Natus RetCam Envision, 130° FOV; pediatric wide-field fundus photograph
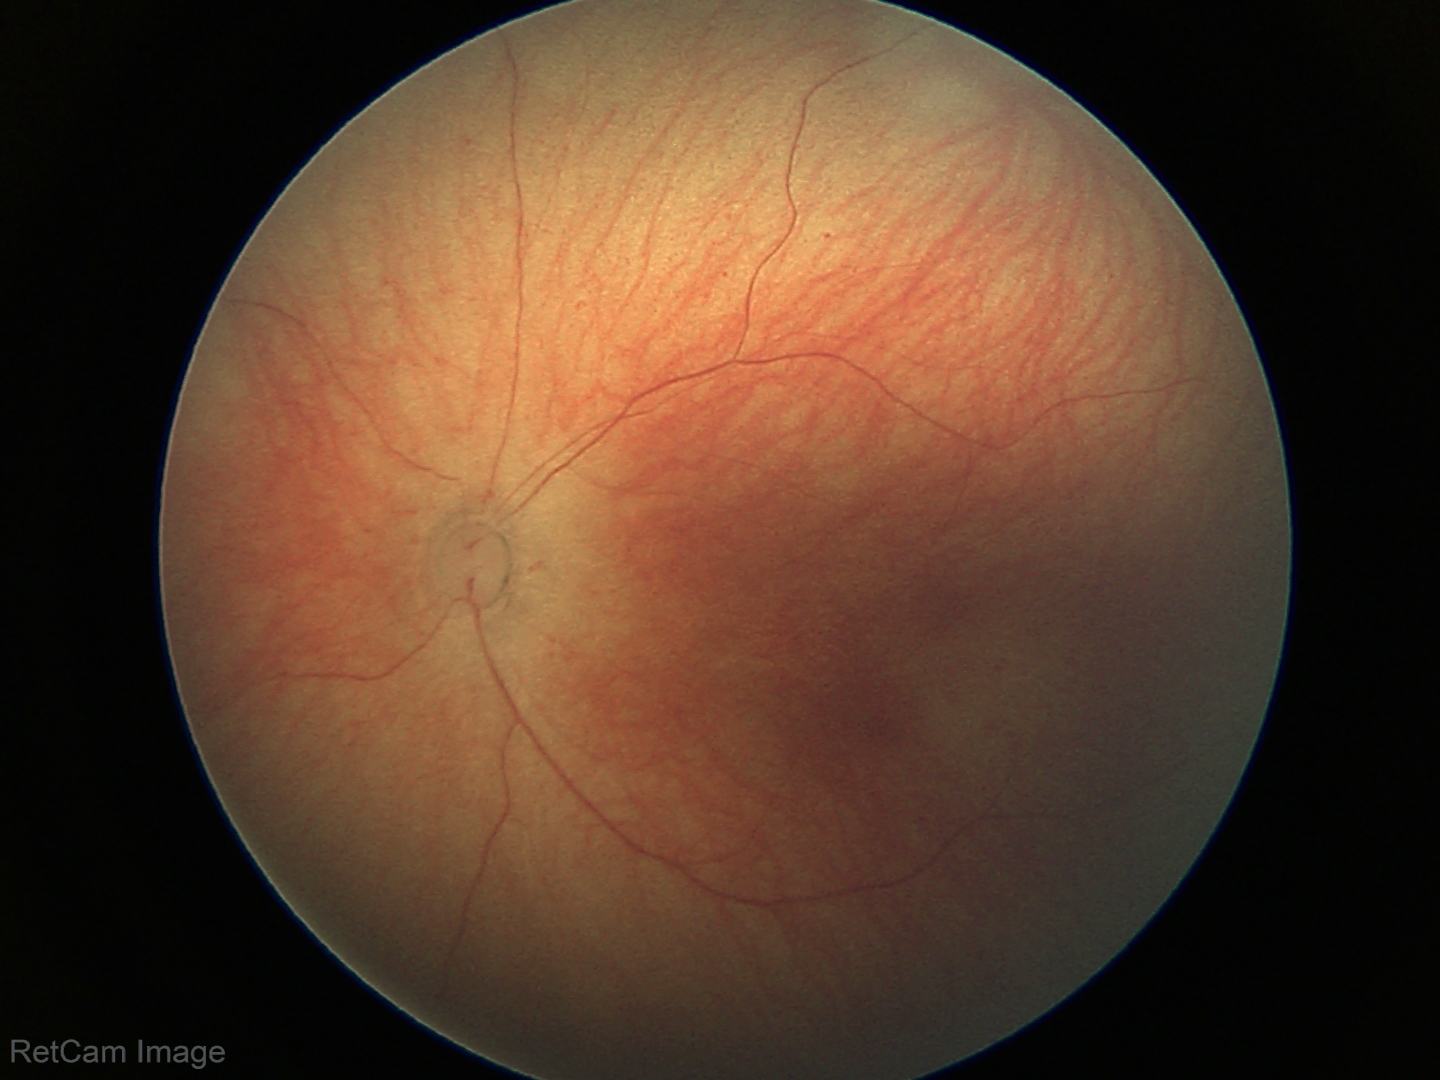
Screening diagnosis: physiological finding.